2228x1652px: 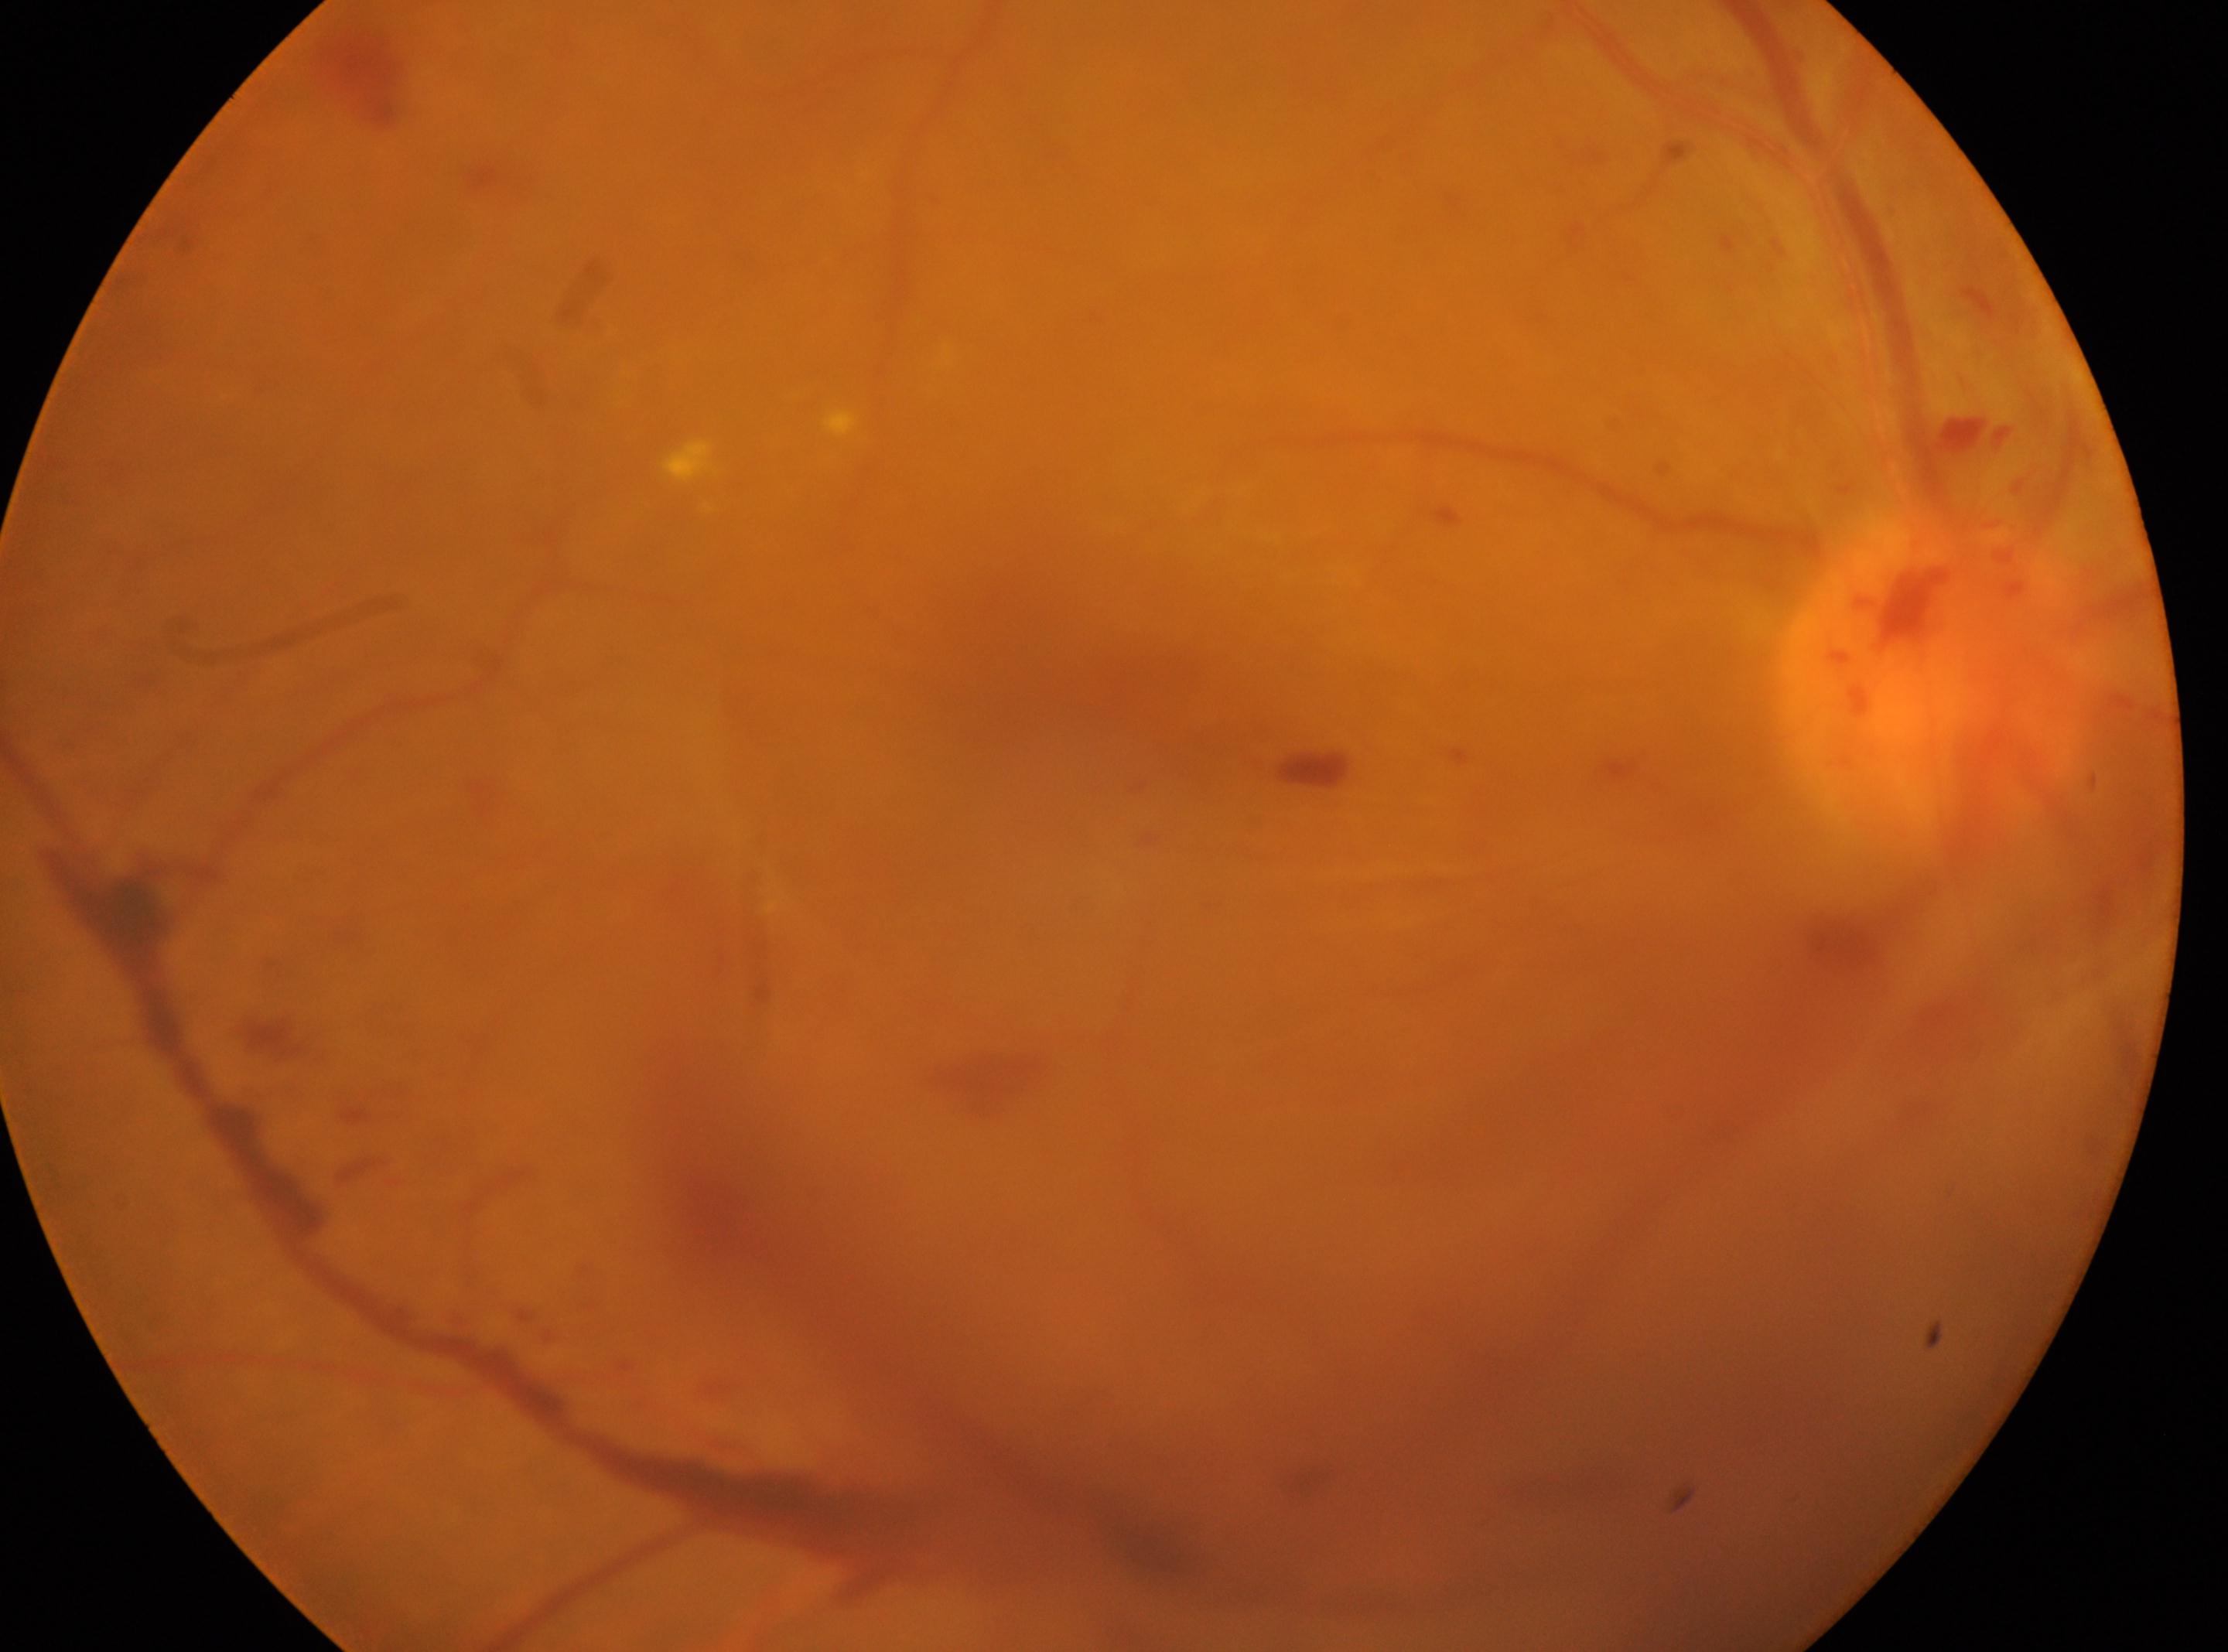 DR stage = grade 4 | eye = OD | macular center = [1032, 676] | ONH = [1936, 678].